Fundus photo taken with a portable handheld camera
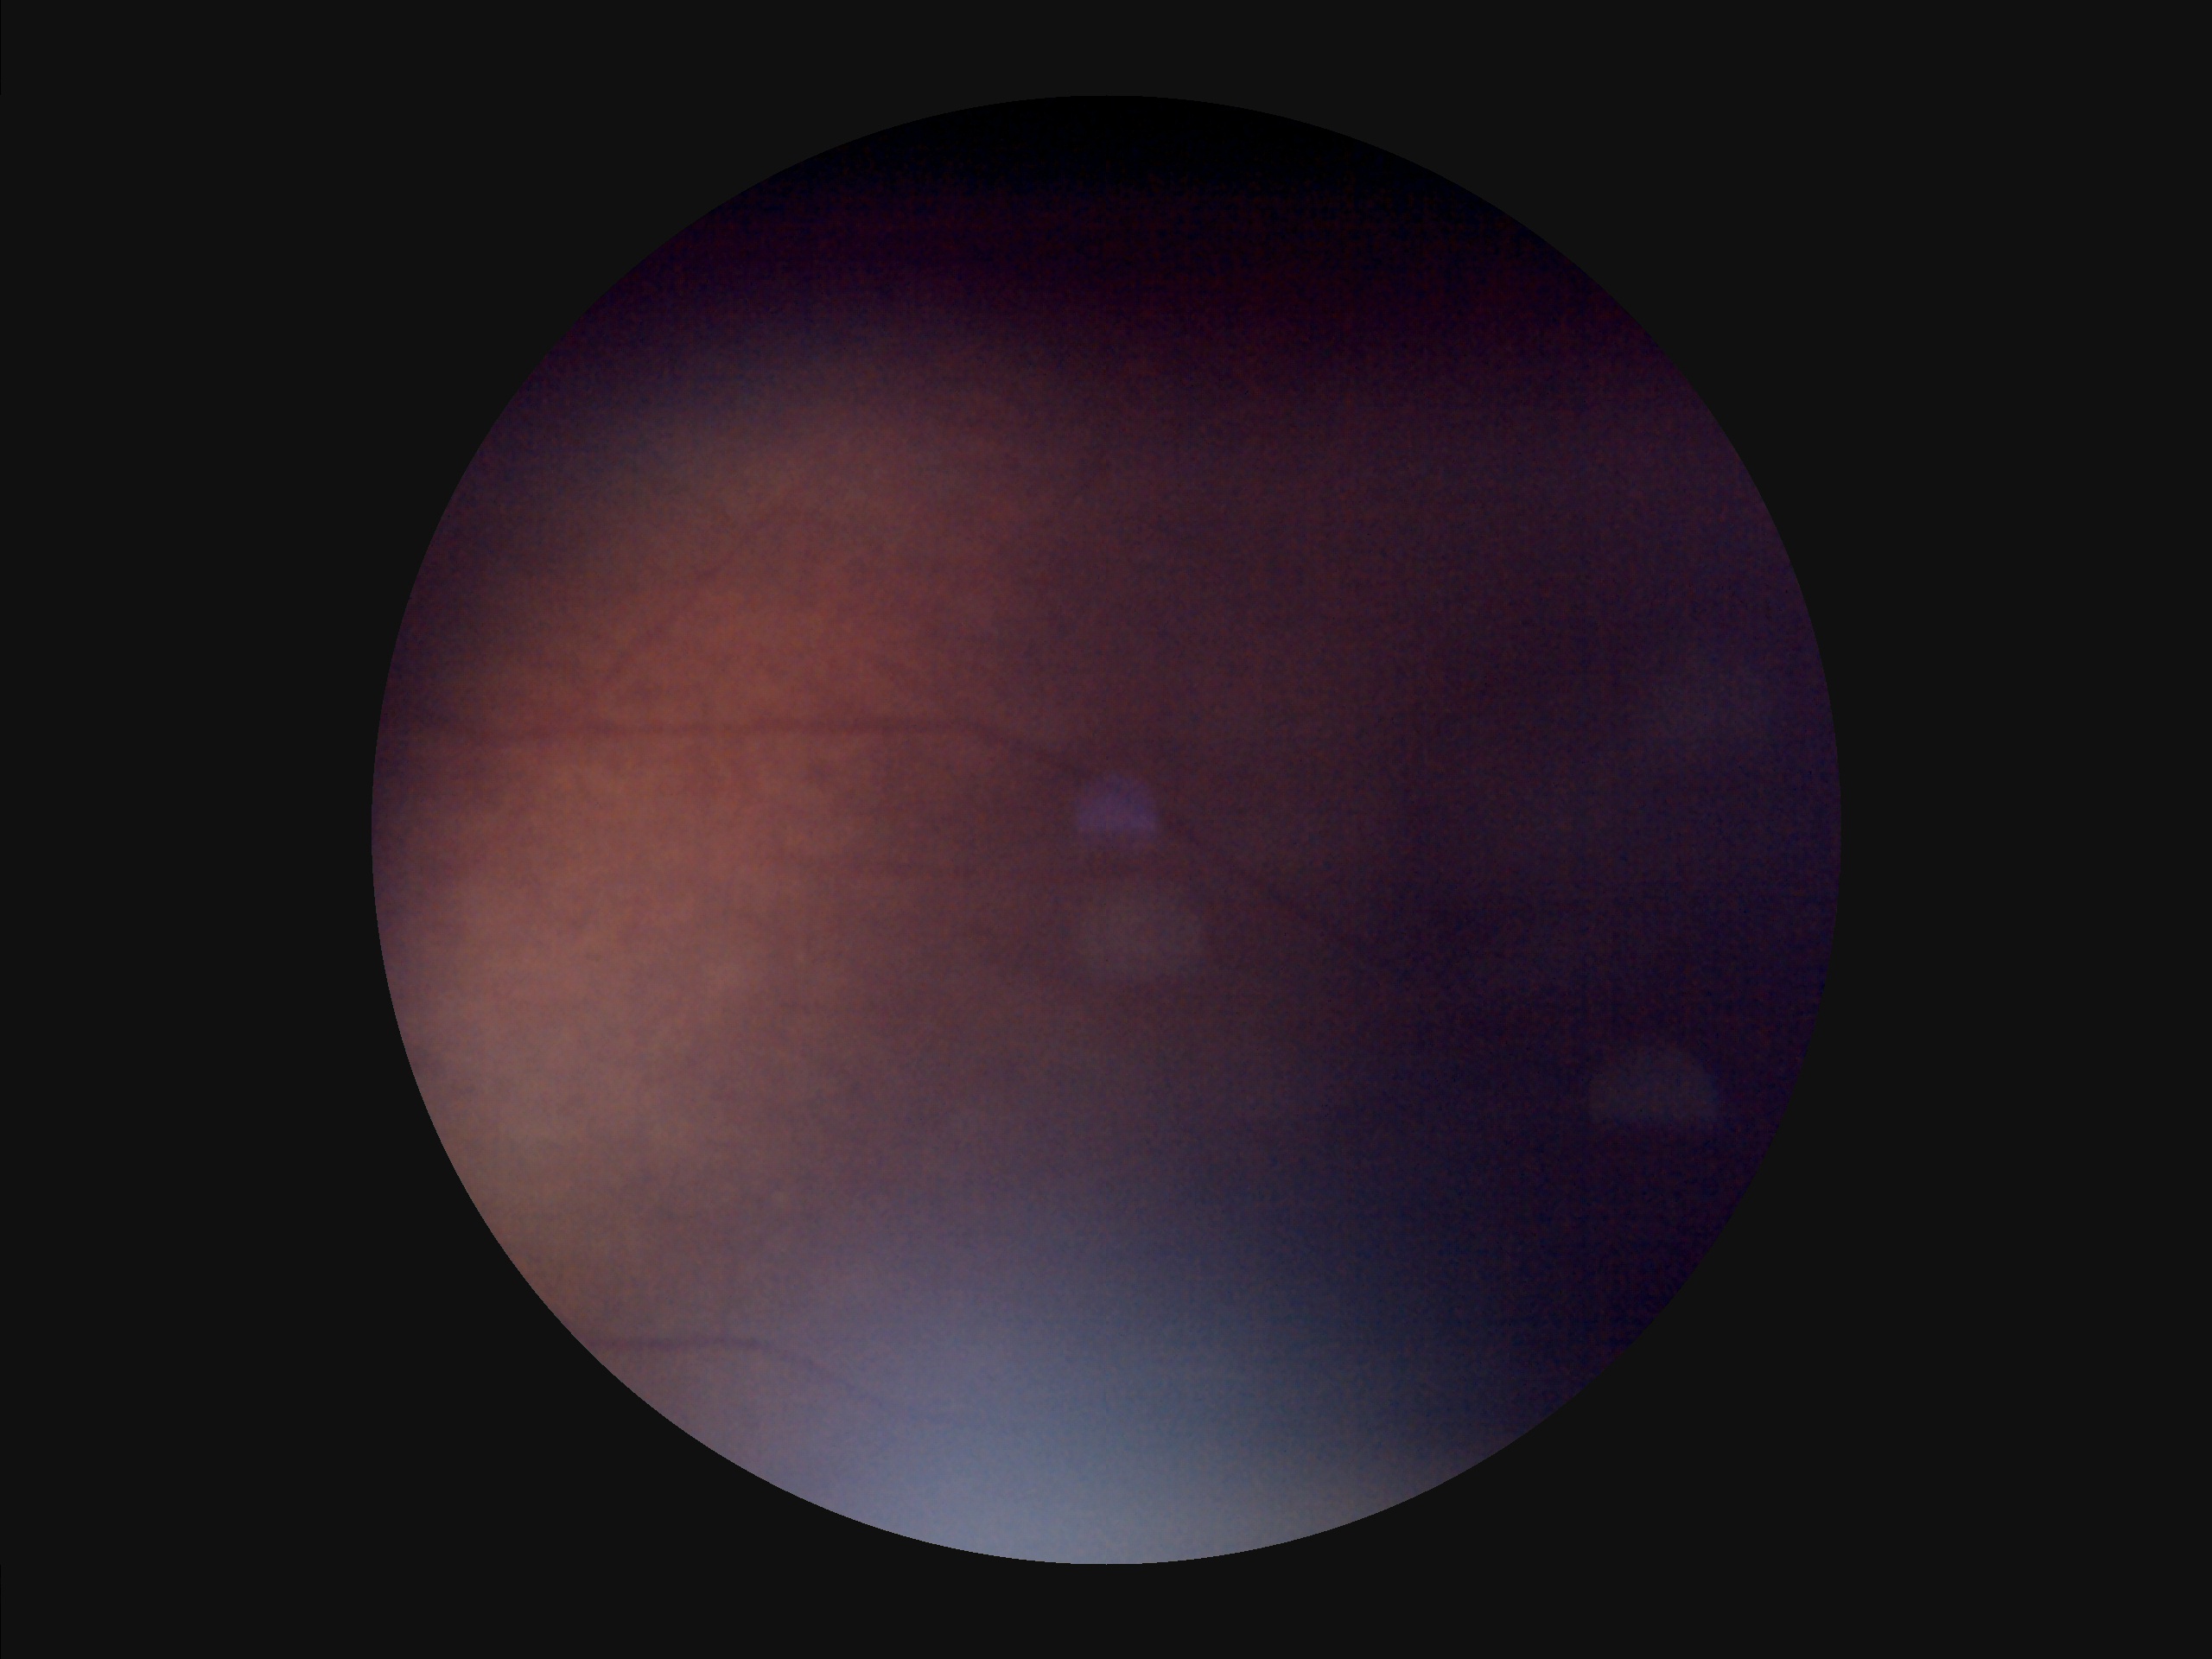

There is over- or under-exposure or a color cast. Image quality is inadequate for diagnostic use. Poor dynamic range. Noticeable blur in the optic disc, vessels, or background.